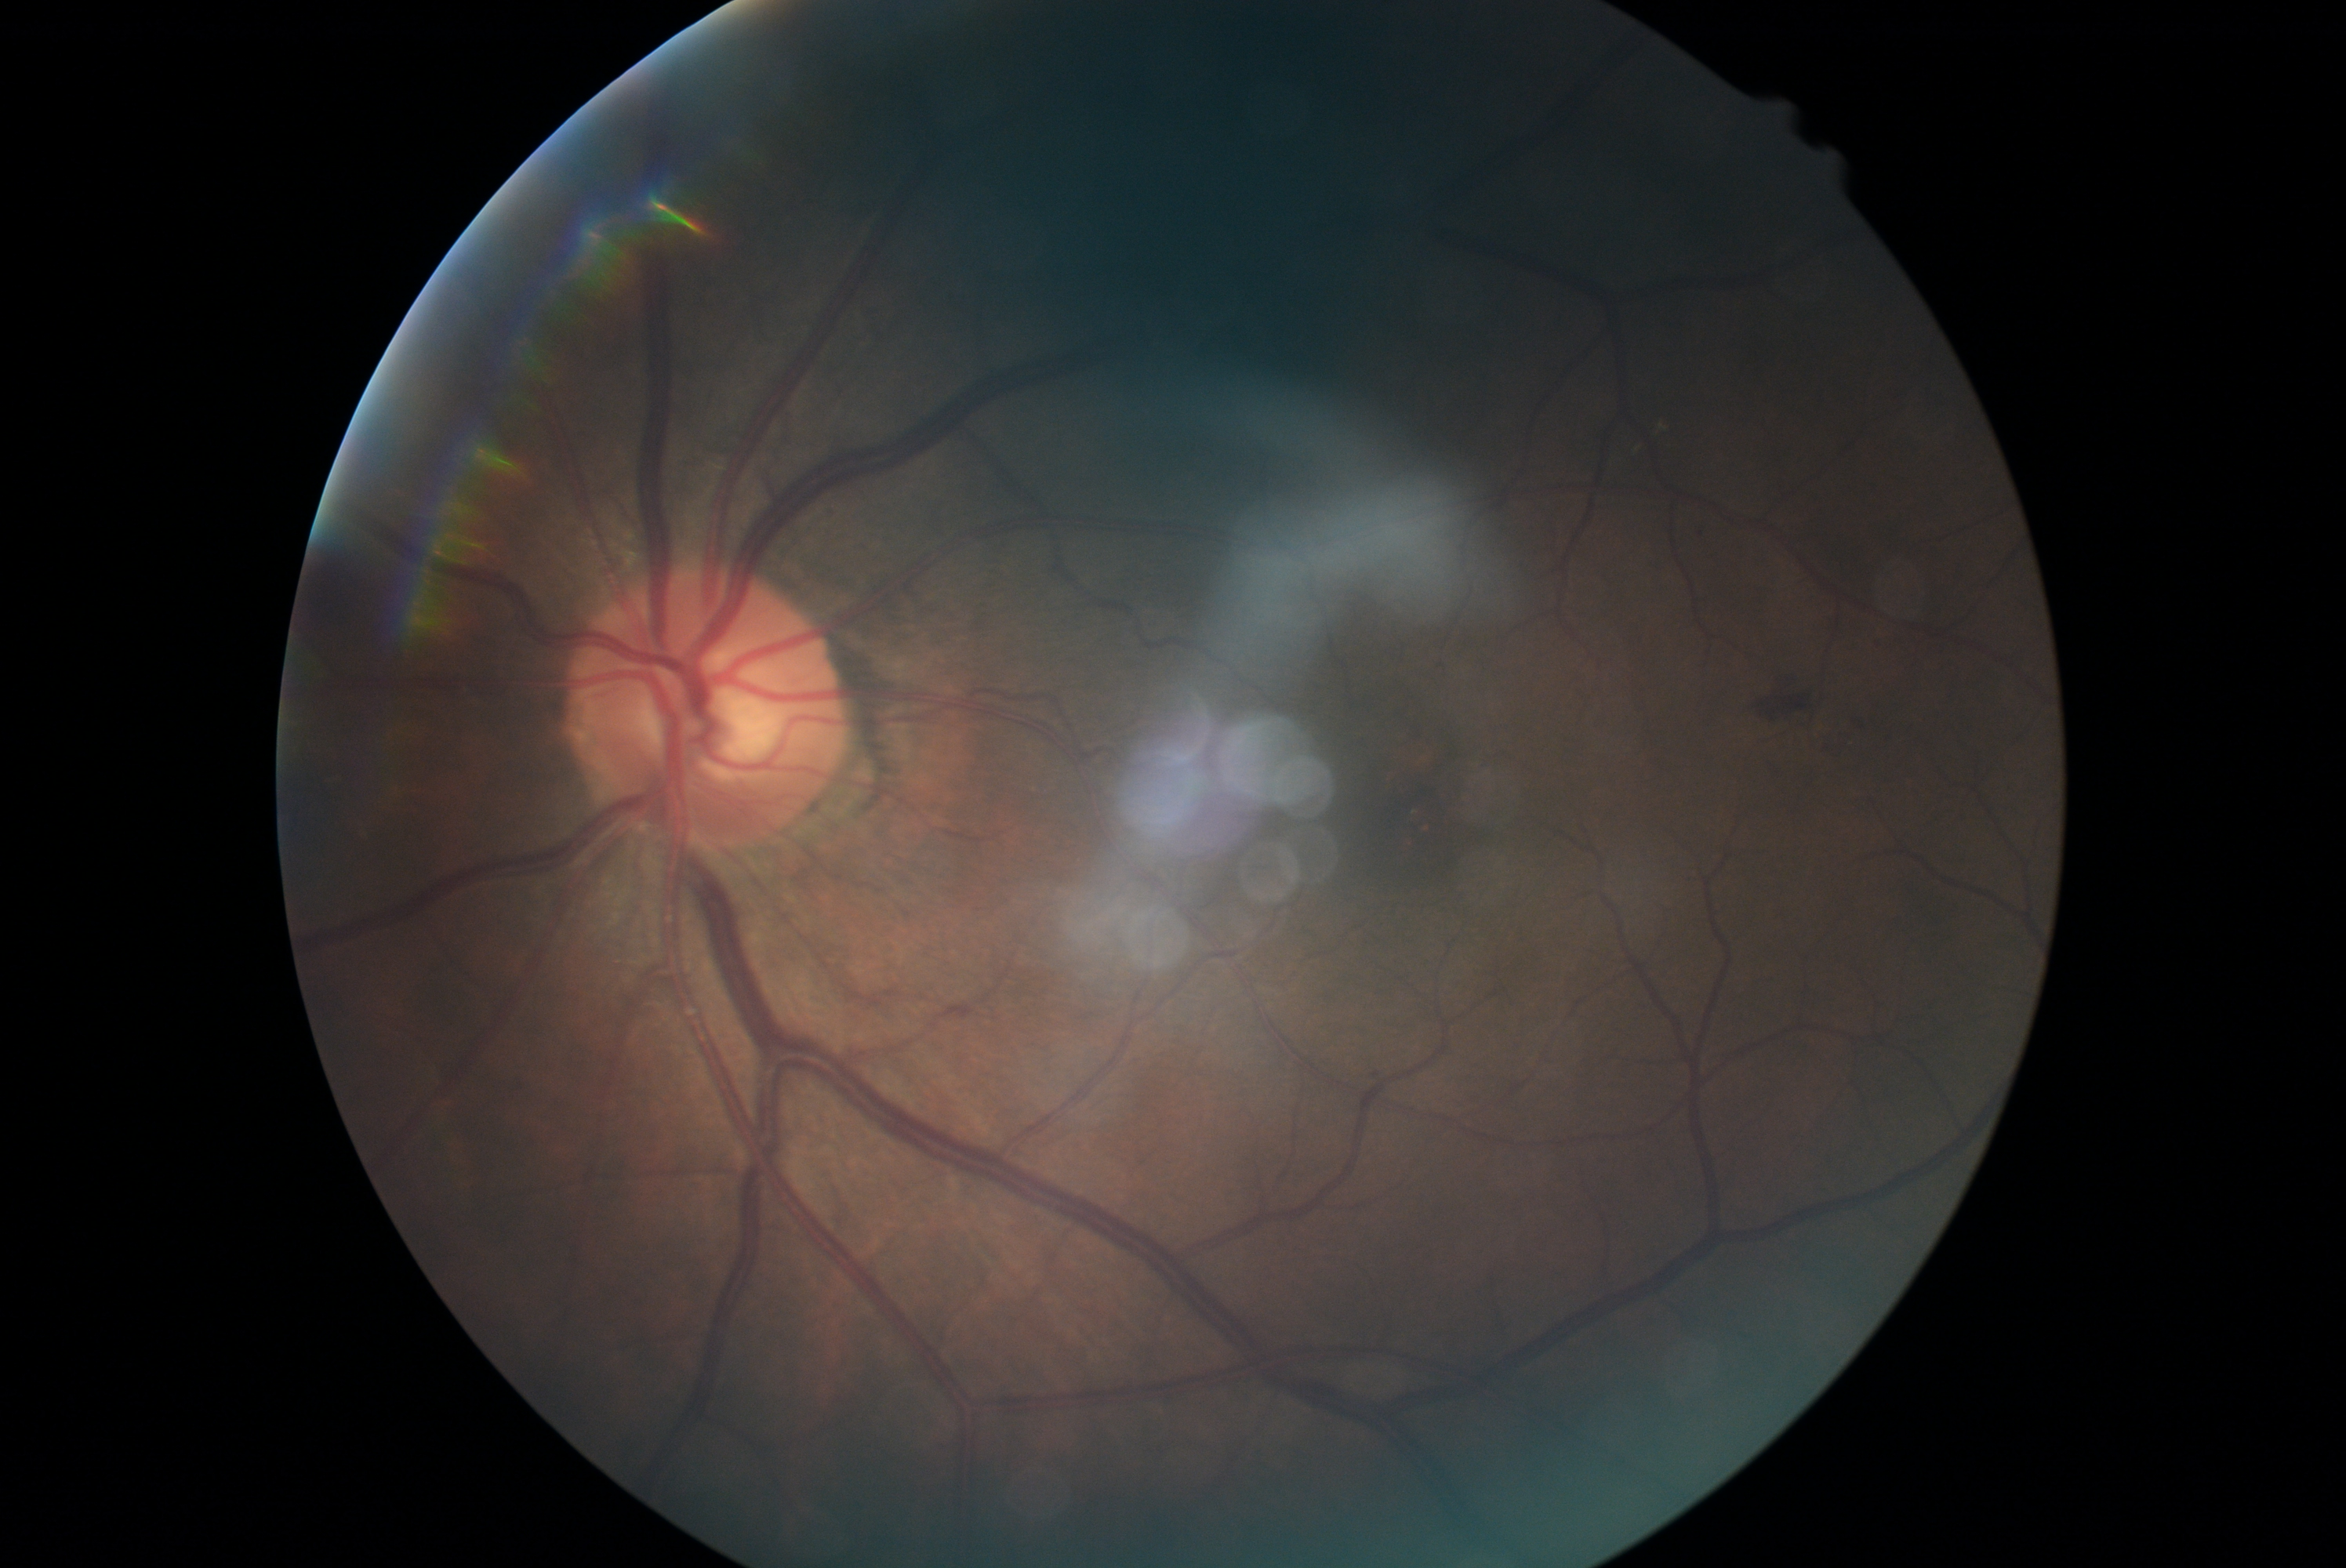
diabetic retinopathy (DR) = grade 2 (moderate NPDR)